Camera: NIDEK AFC-230 · posterior pole color fundus photograph · modified Davis classification · nonmydriatic fundus photograph
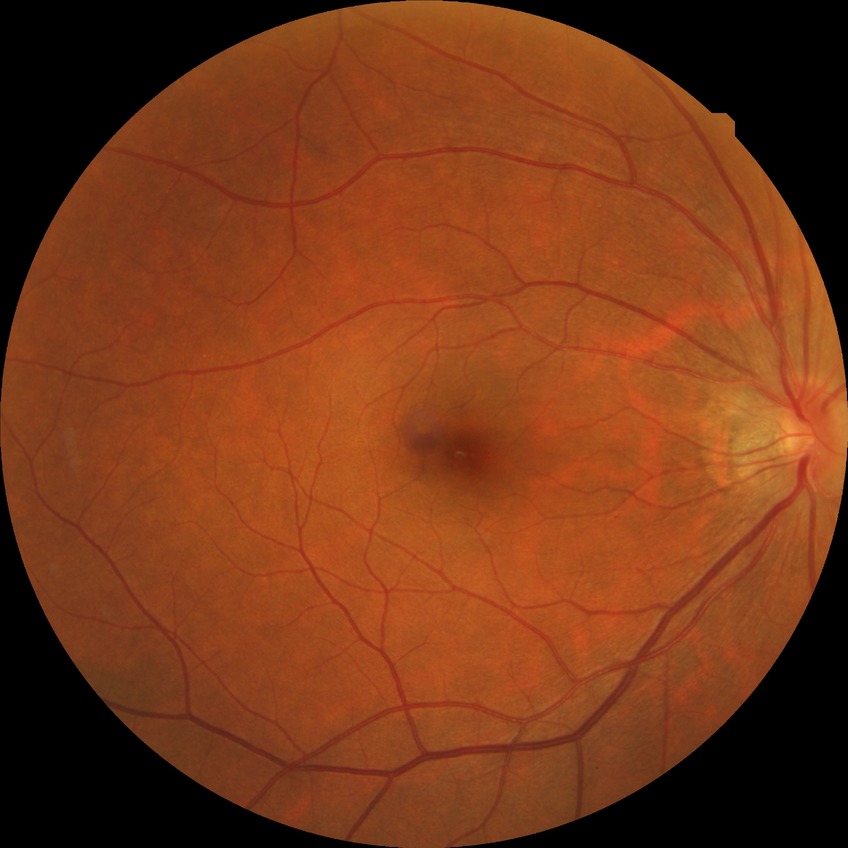 Diabetic retinopathy (DR) is NDR (no diabetic retinopathy).